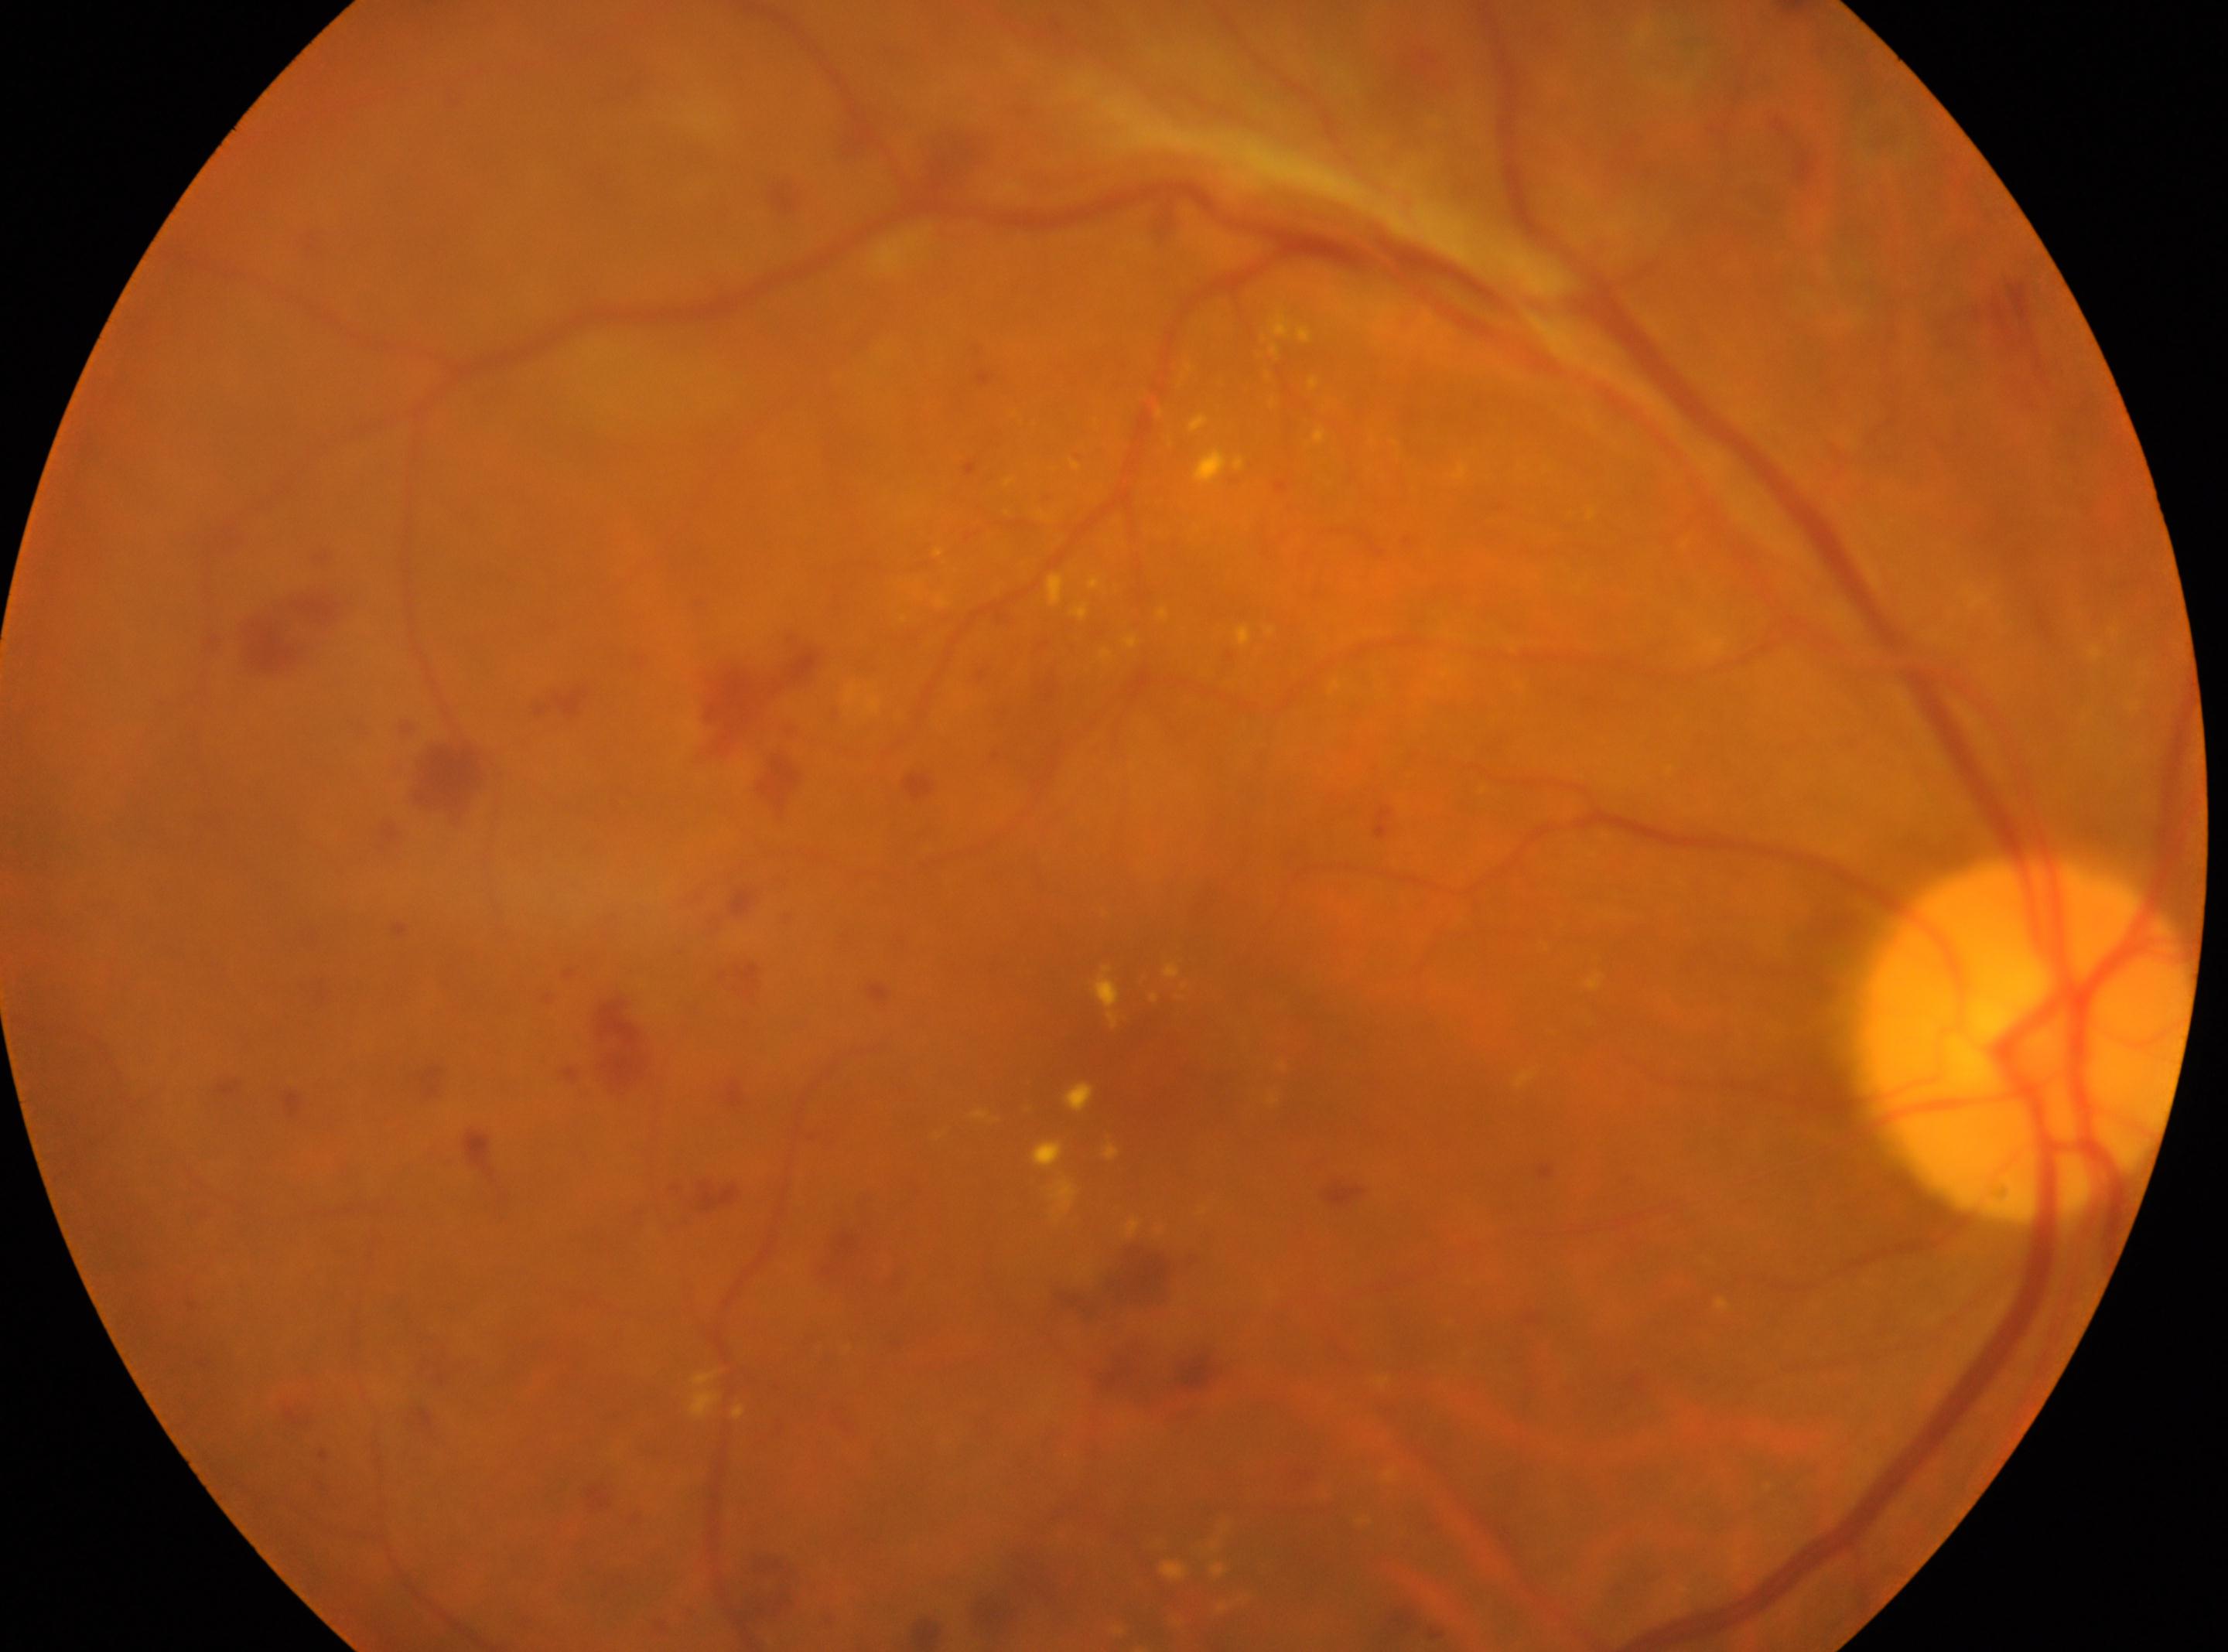
Fovea located at 1150, 1056.
DR severity: grade 4.
Optic disk: 2025, 1039.
Eye: right eye.